45° field of view: 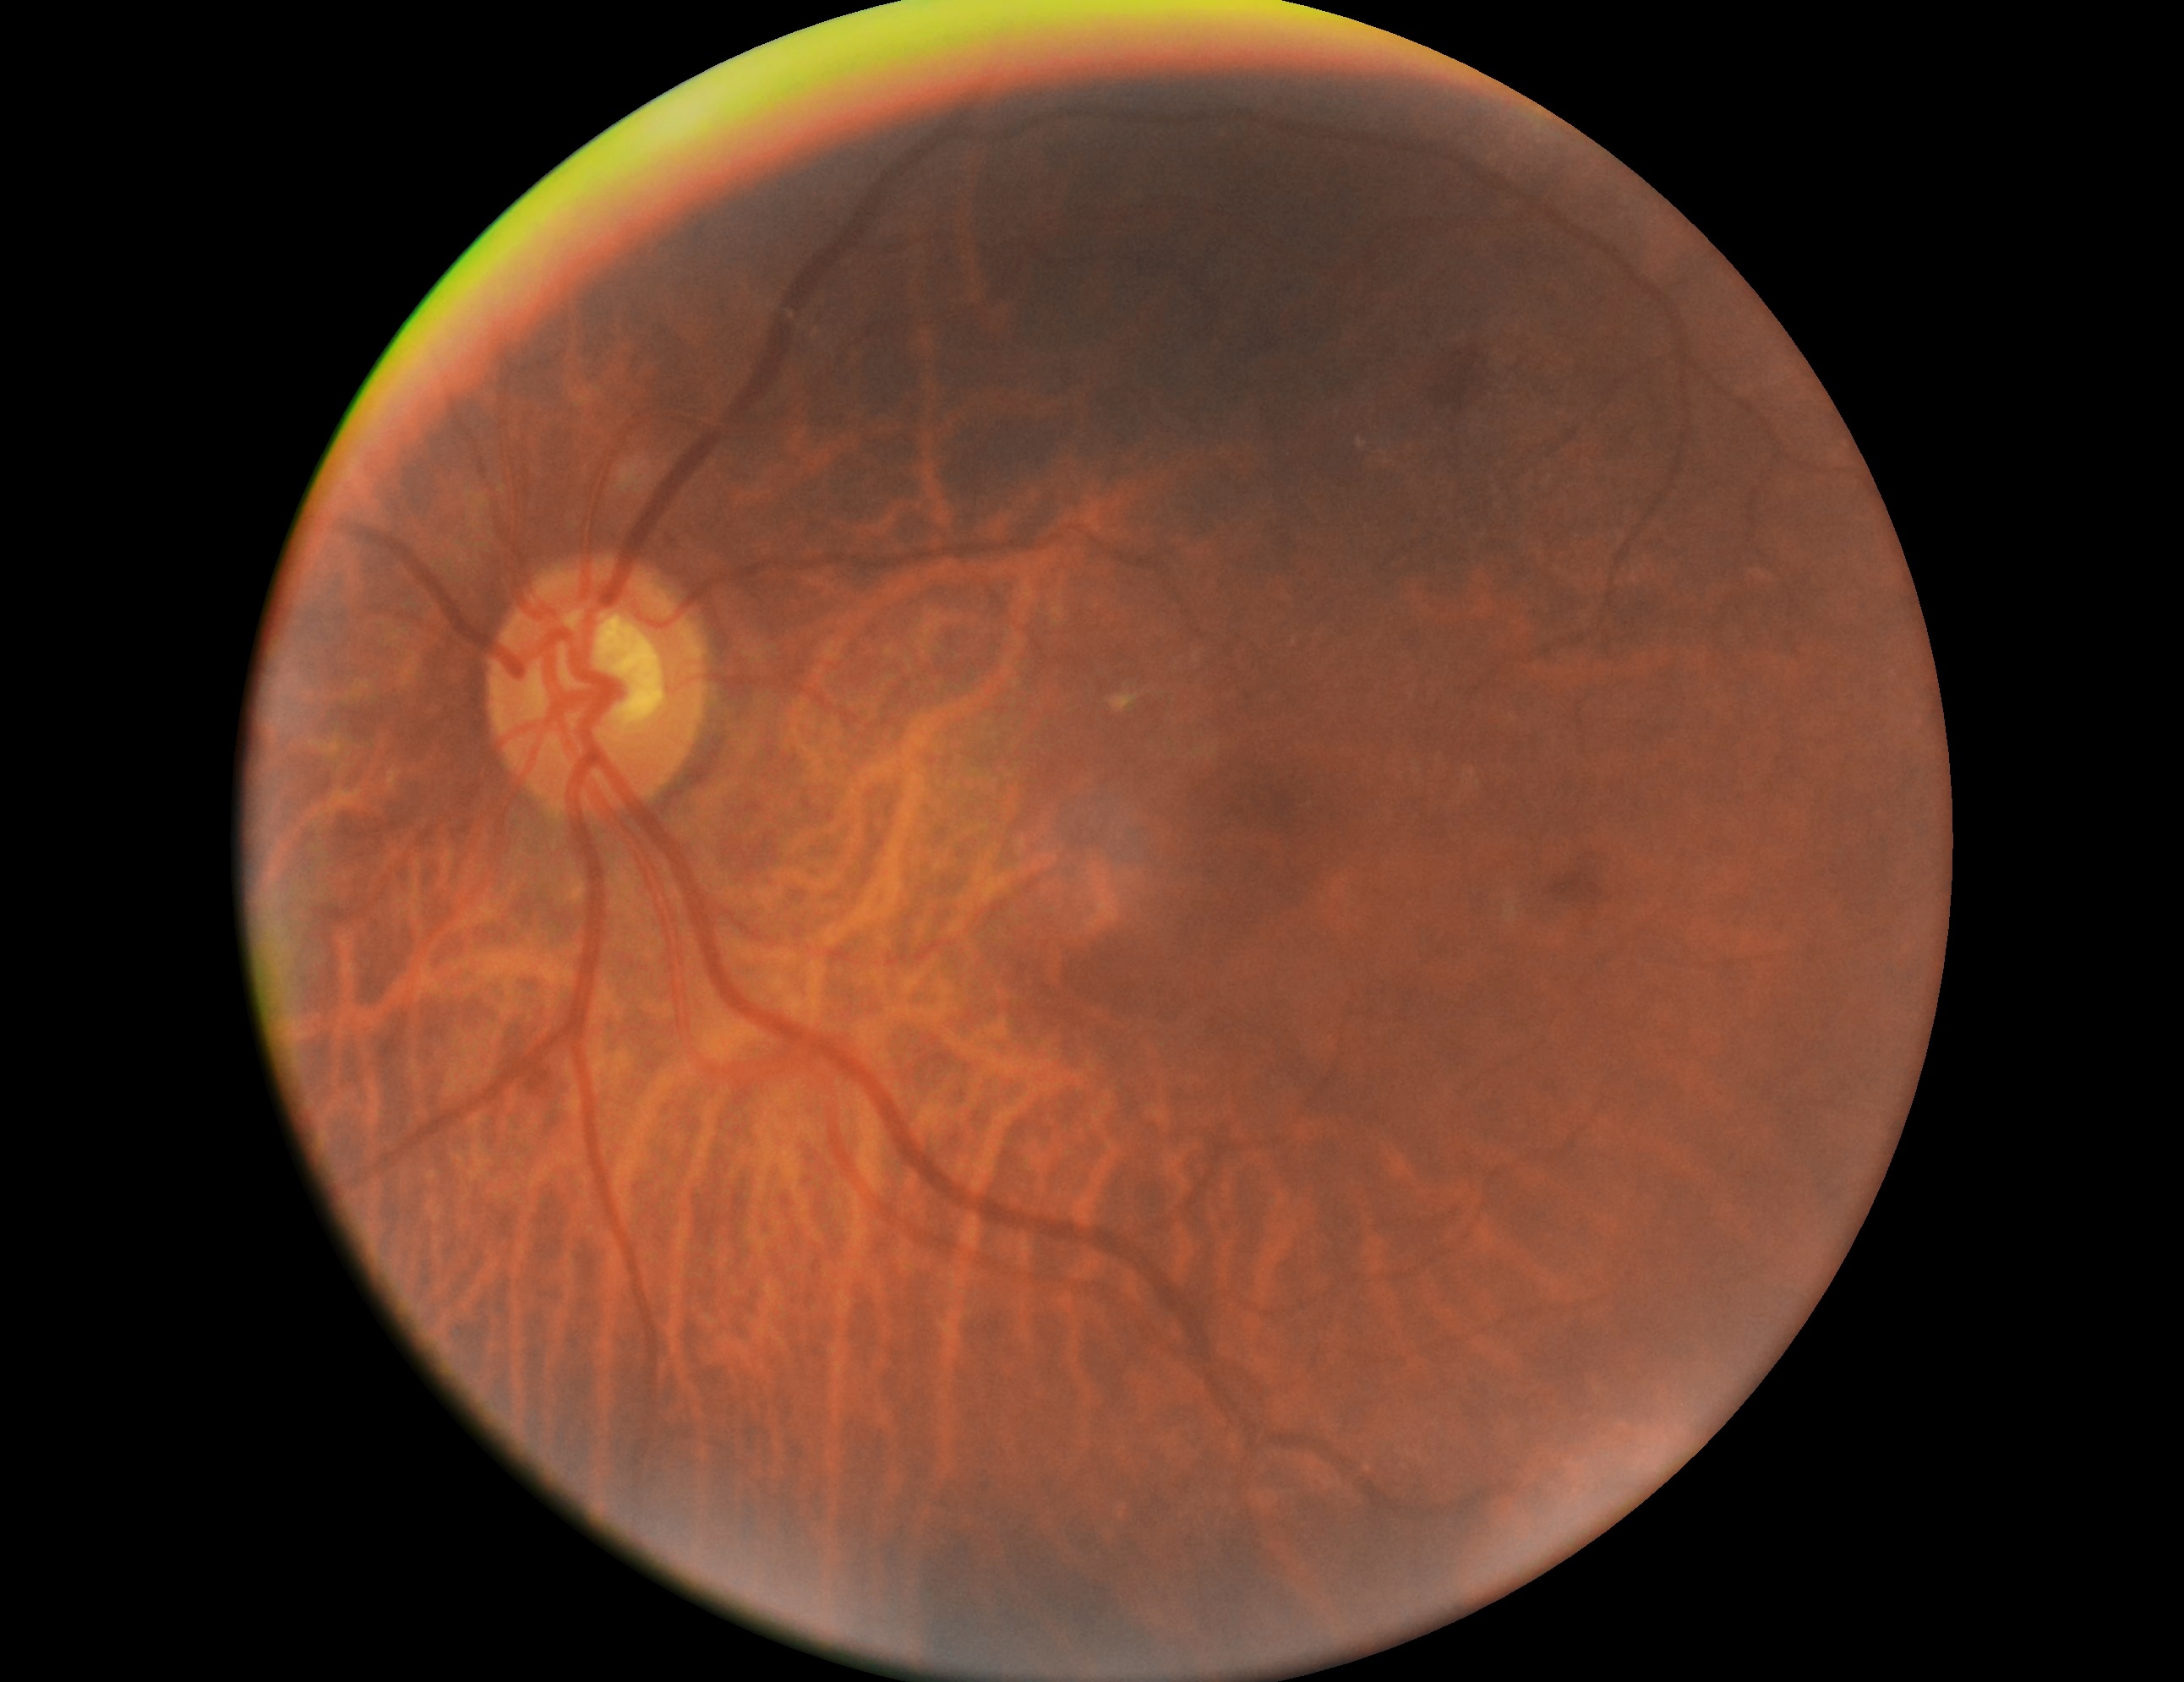
DR stage: moderate non-proliferative diabetic retinopathy (grade 2).